2352x1568. FOV: 45 degrees:
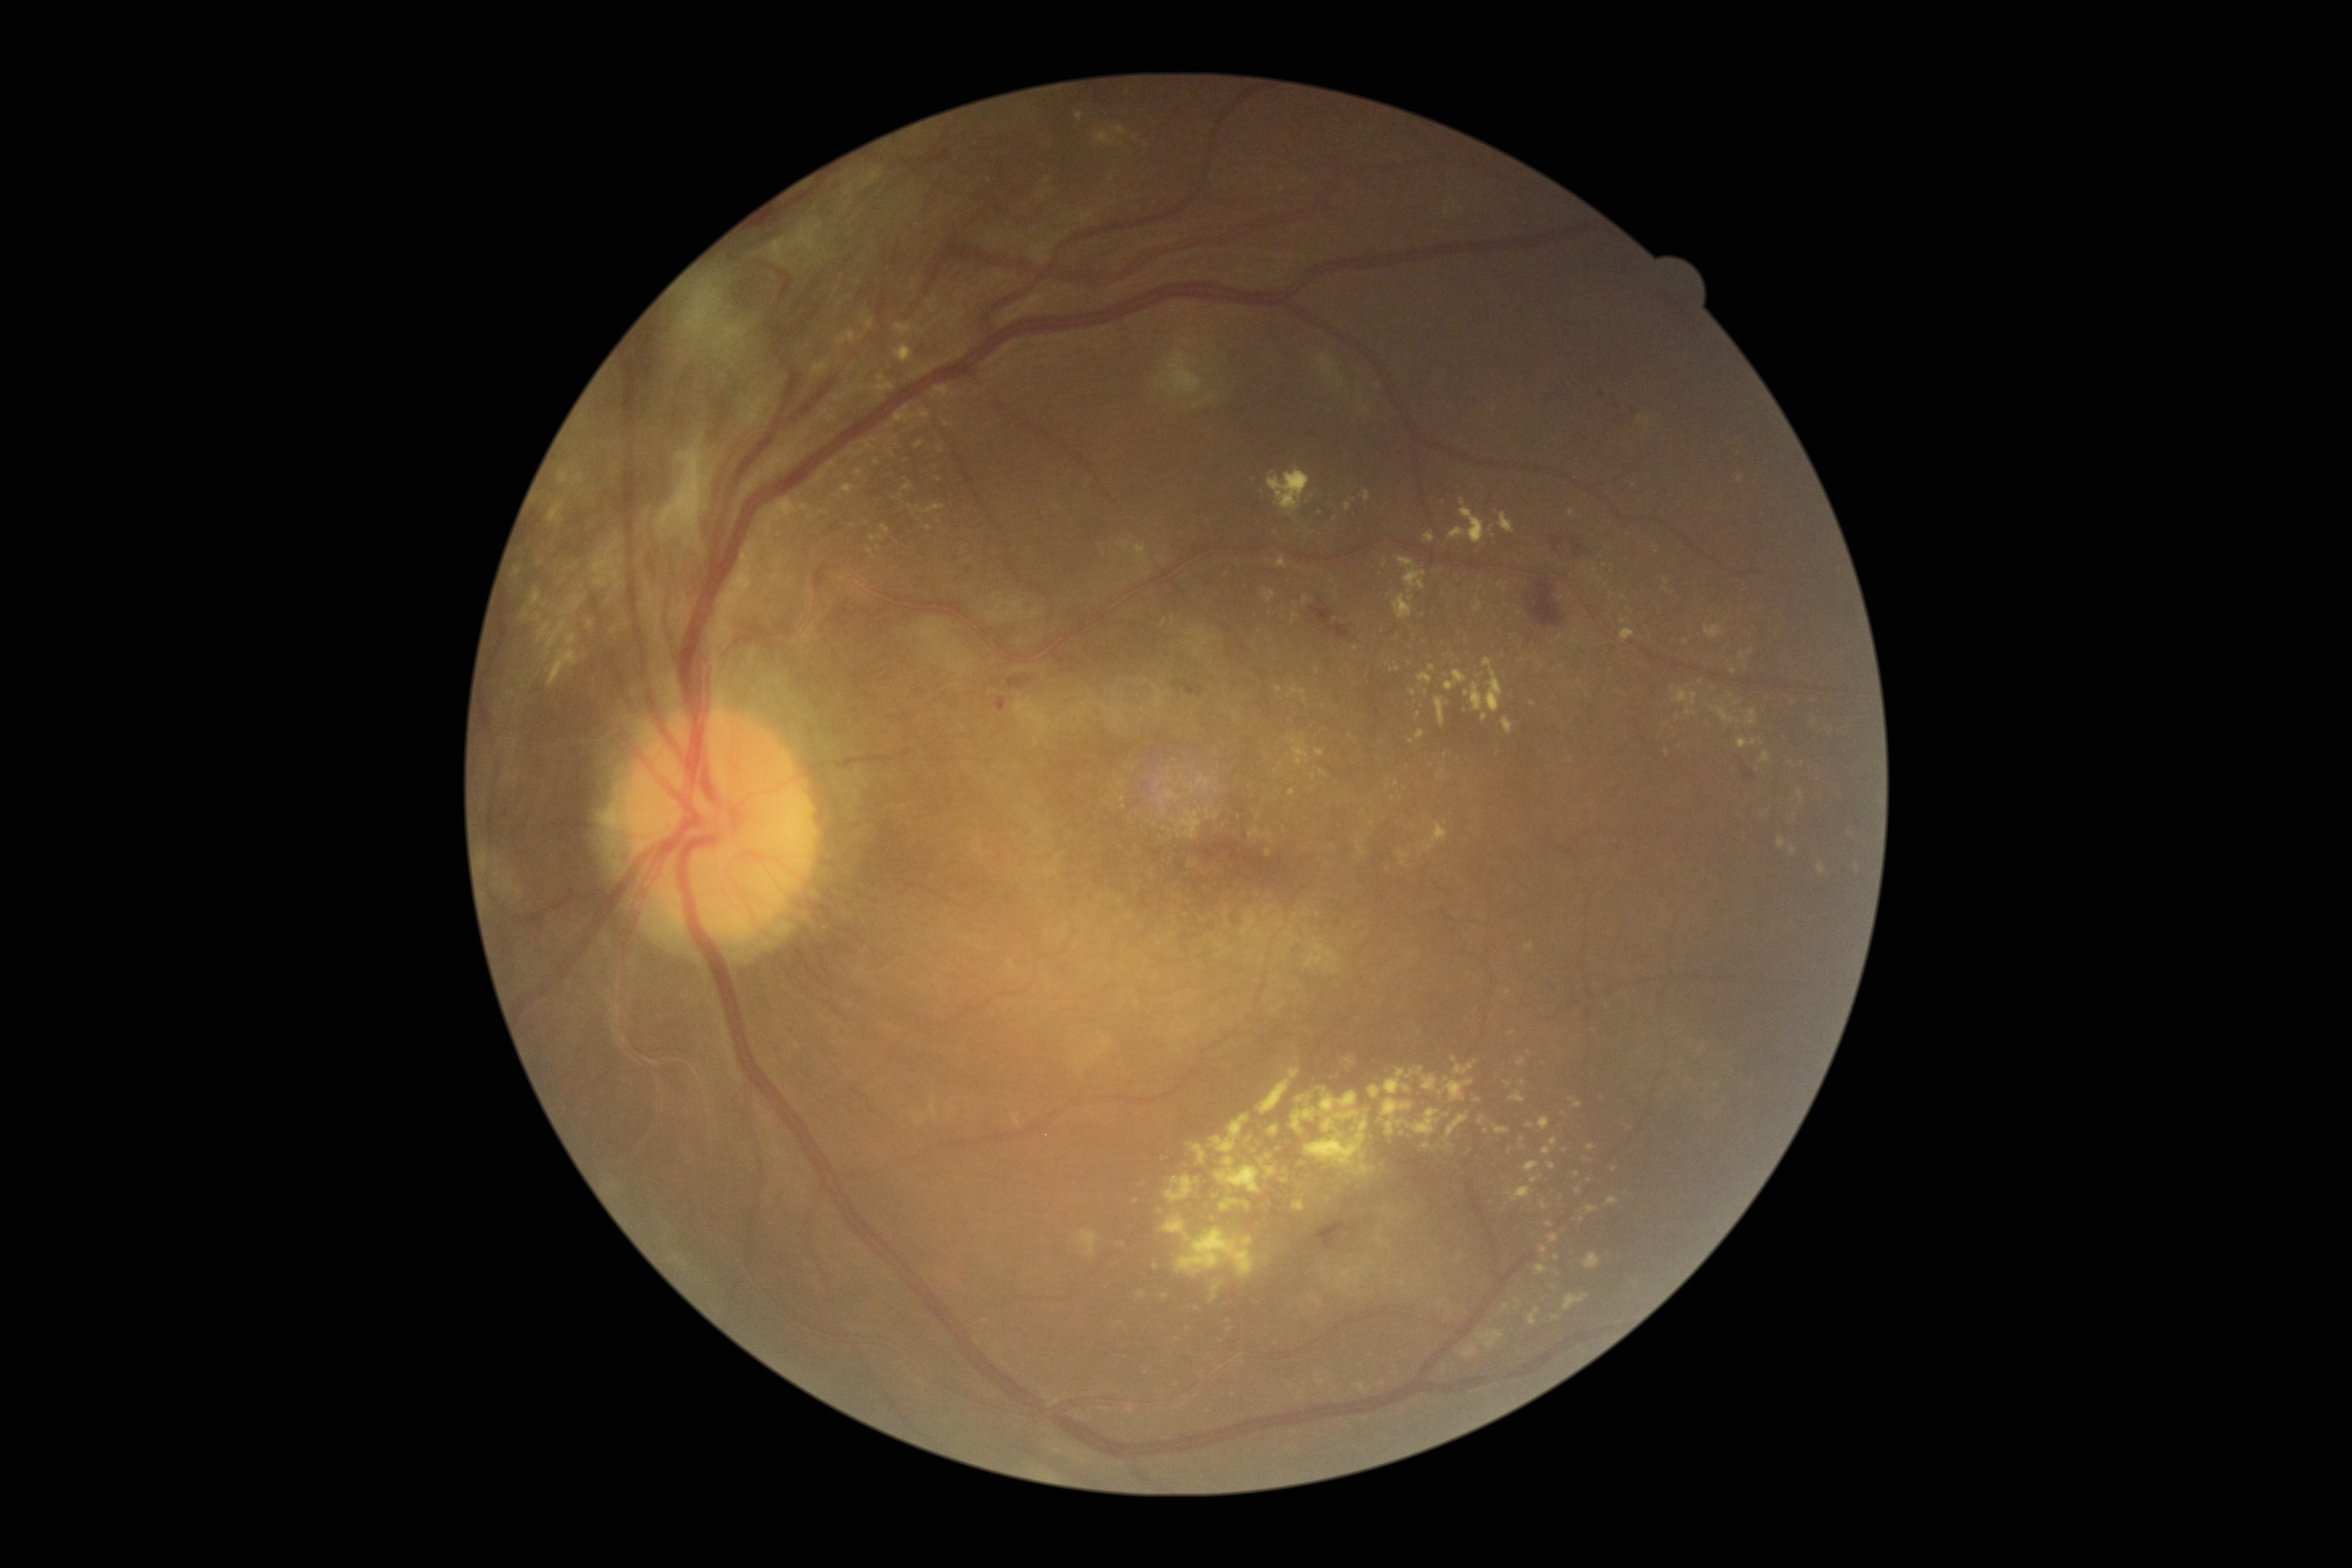 {"partial":true,"dr_grade":4,"lesions":{"se":[[1163,353,1202,395],[1330,373,1345,389],[1317,353,1338,377],[1202,396,1215,403]],"se_small":[[1348,393],[1379,386],[1165,375]],"ma":[[1615,416,1624,423]],"ma_small":[[1633,414],[1602,394]],"he":[[1007,676,1033,690],[1744,769,1756,780],[1174,682,1203,696],[1552,538,1566,552],[1529,579,1566,626],[996,696,1007,711],[1315,1220,1358,1249],[648,562,656,572],[1310,607,1350,639],[1570,537,1584,556]],"he_small":[[1741,761]],"ex":[[1621,629,1635,641],[1162,1214,1256,1278],[1503,1080,1513,1087],[1445,1114,1469,1142],[1542,1138,1558,1155],[1576,1186,1581,1194],[1778,835,1786,849],[848,387,858,394],[1509,1186,1534,1202],[1321,1091,1358,1117],[1569,1098,1583,1108],[1319,1086,1327,1092]],"ex_small":[[1793,703],[1136,1201],[1815,721],[1332,581],[940,449],[1146,1372],[1486,1131],[1304,699]]}}